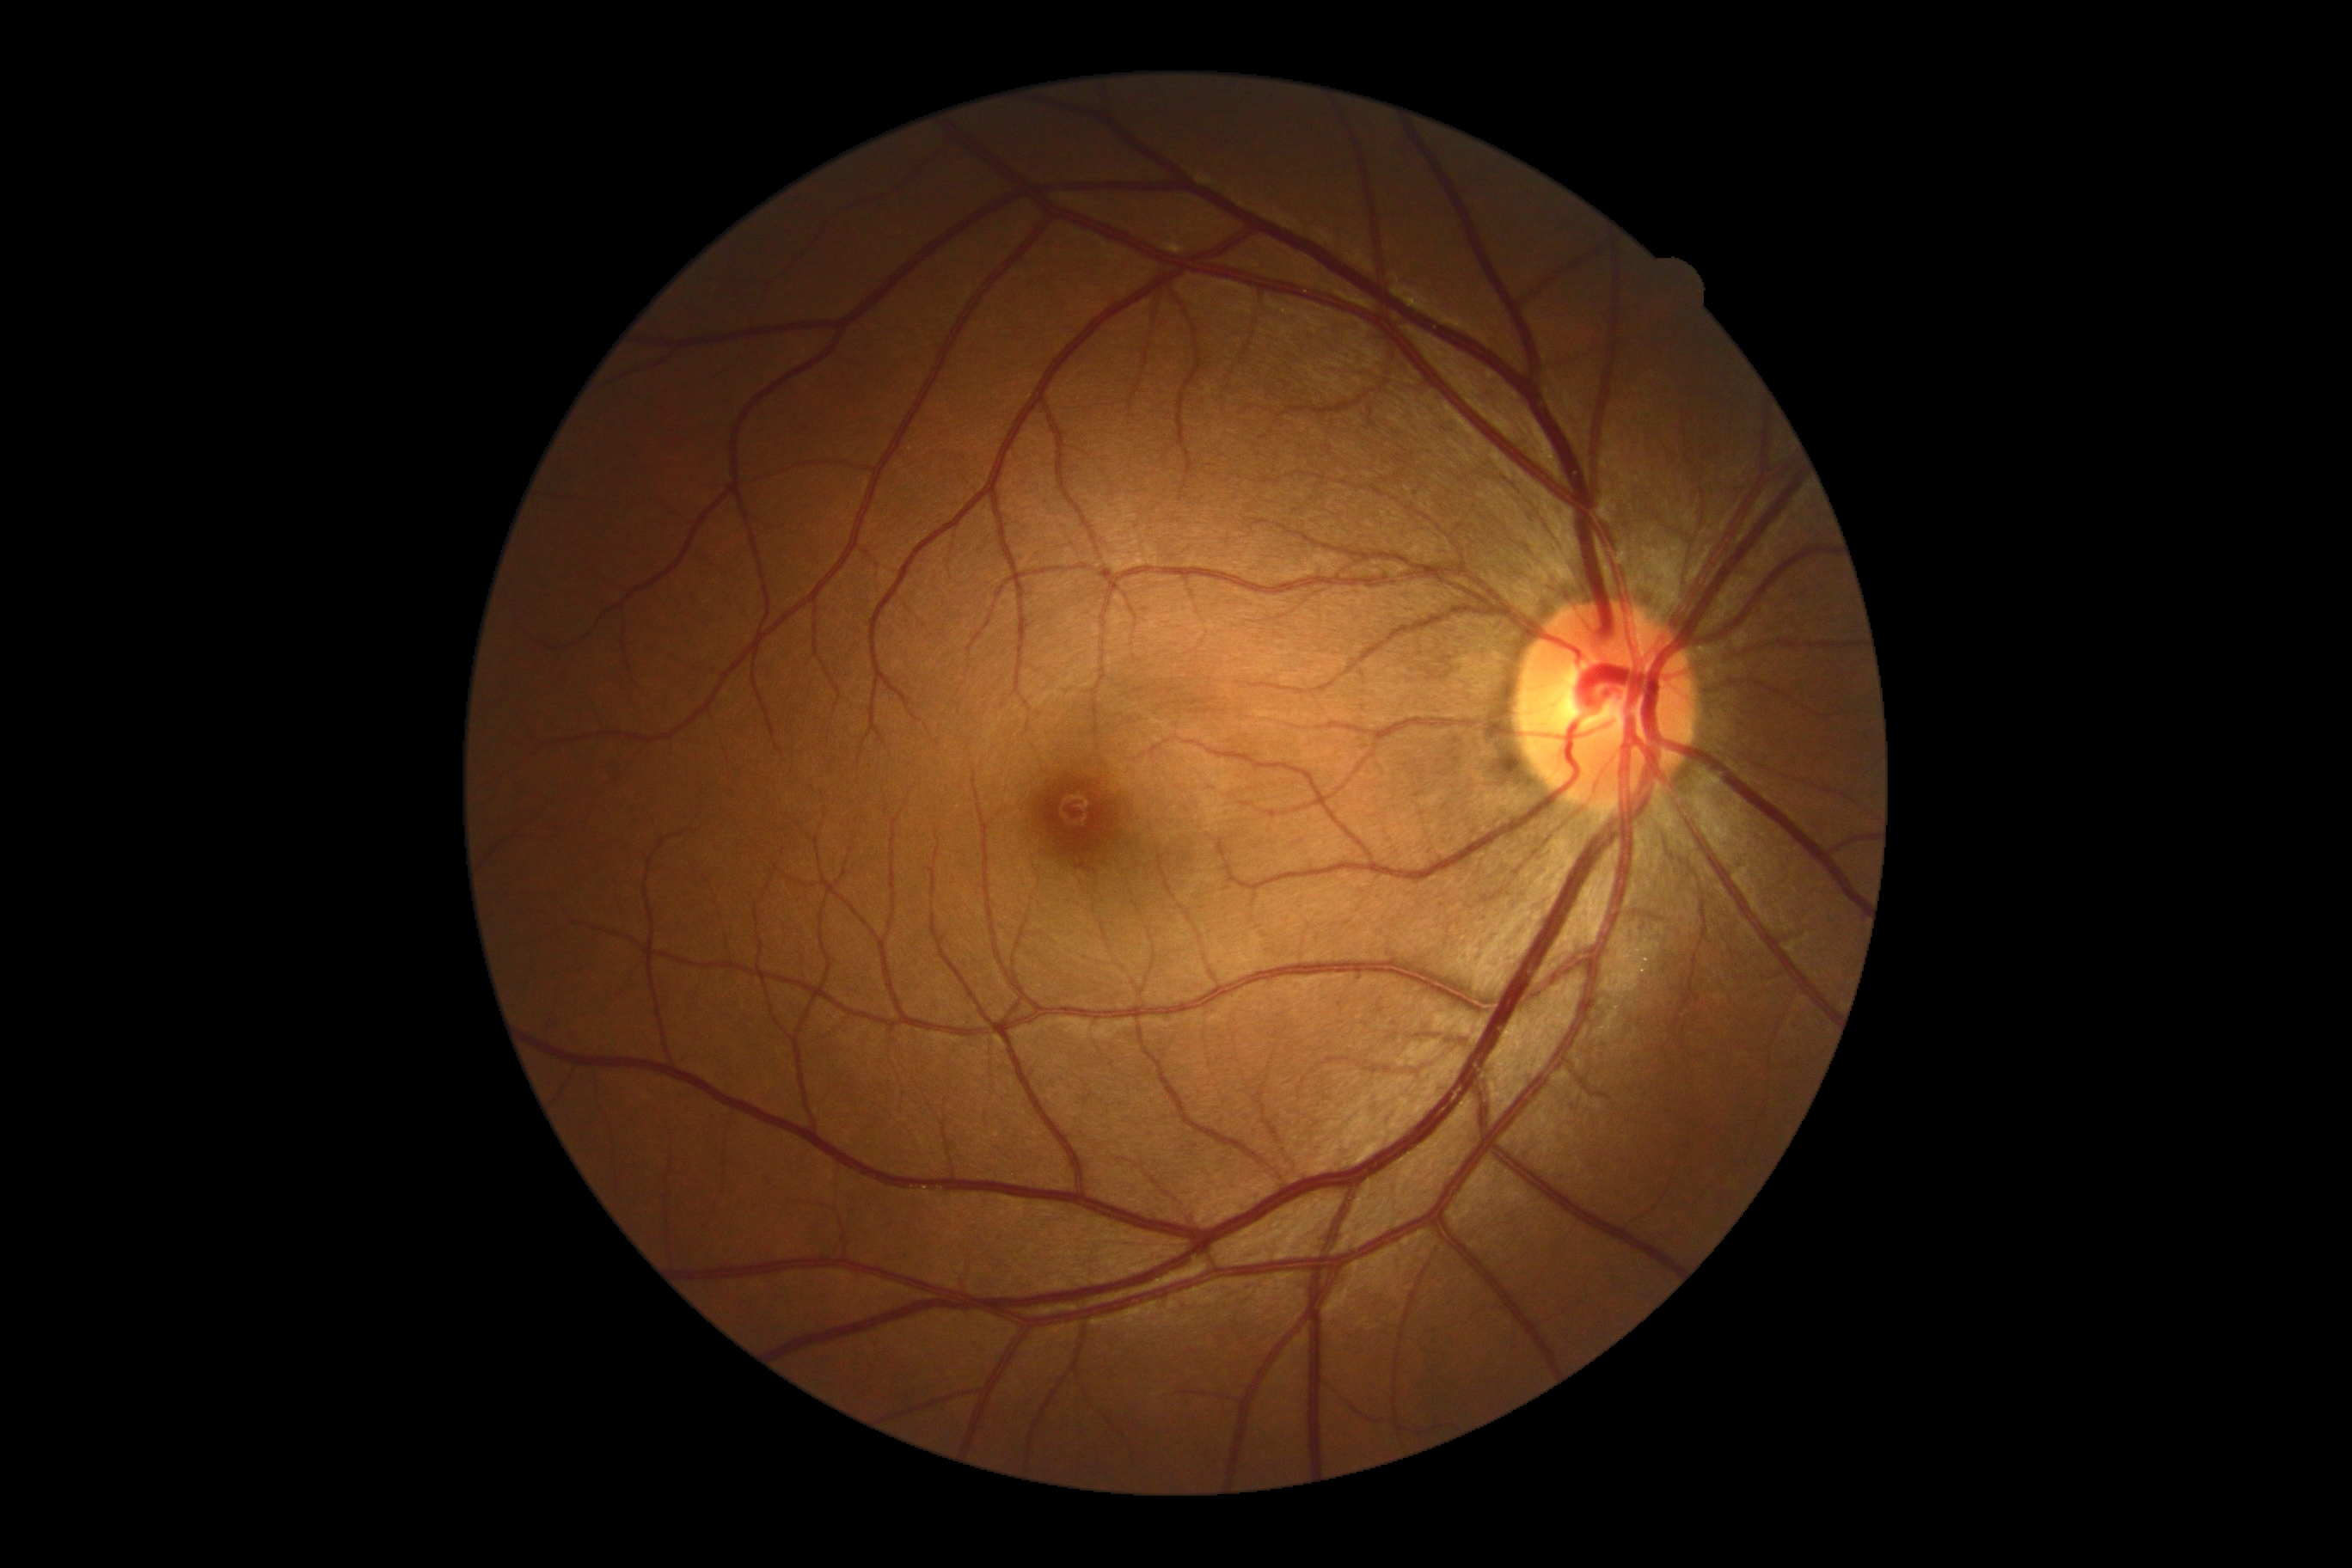

No DR findings.
DR stage is no apparent diabetic retinopathy (grade 0) — no visible signs of diabetic retinopathy.